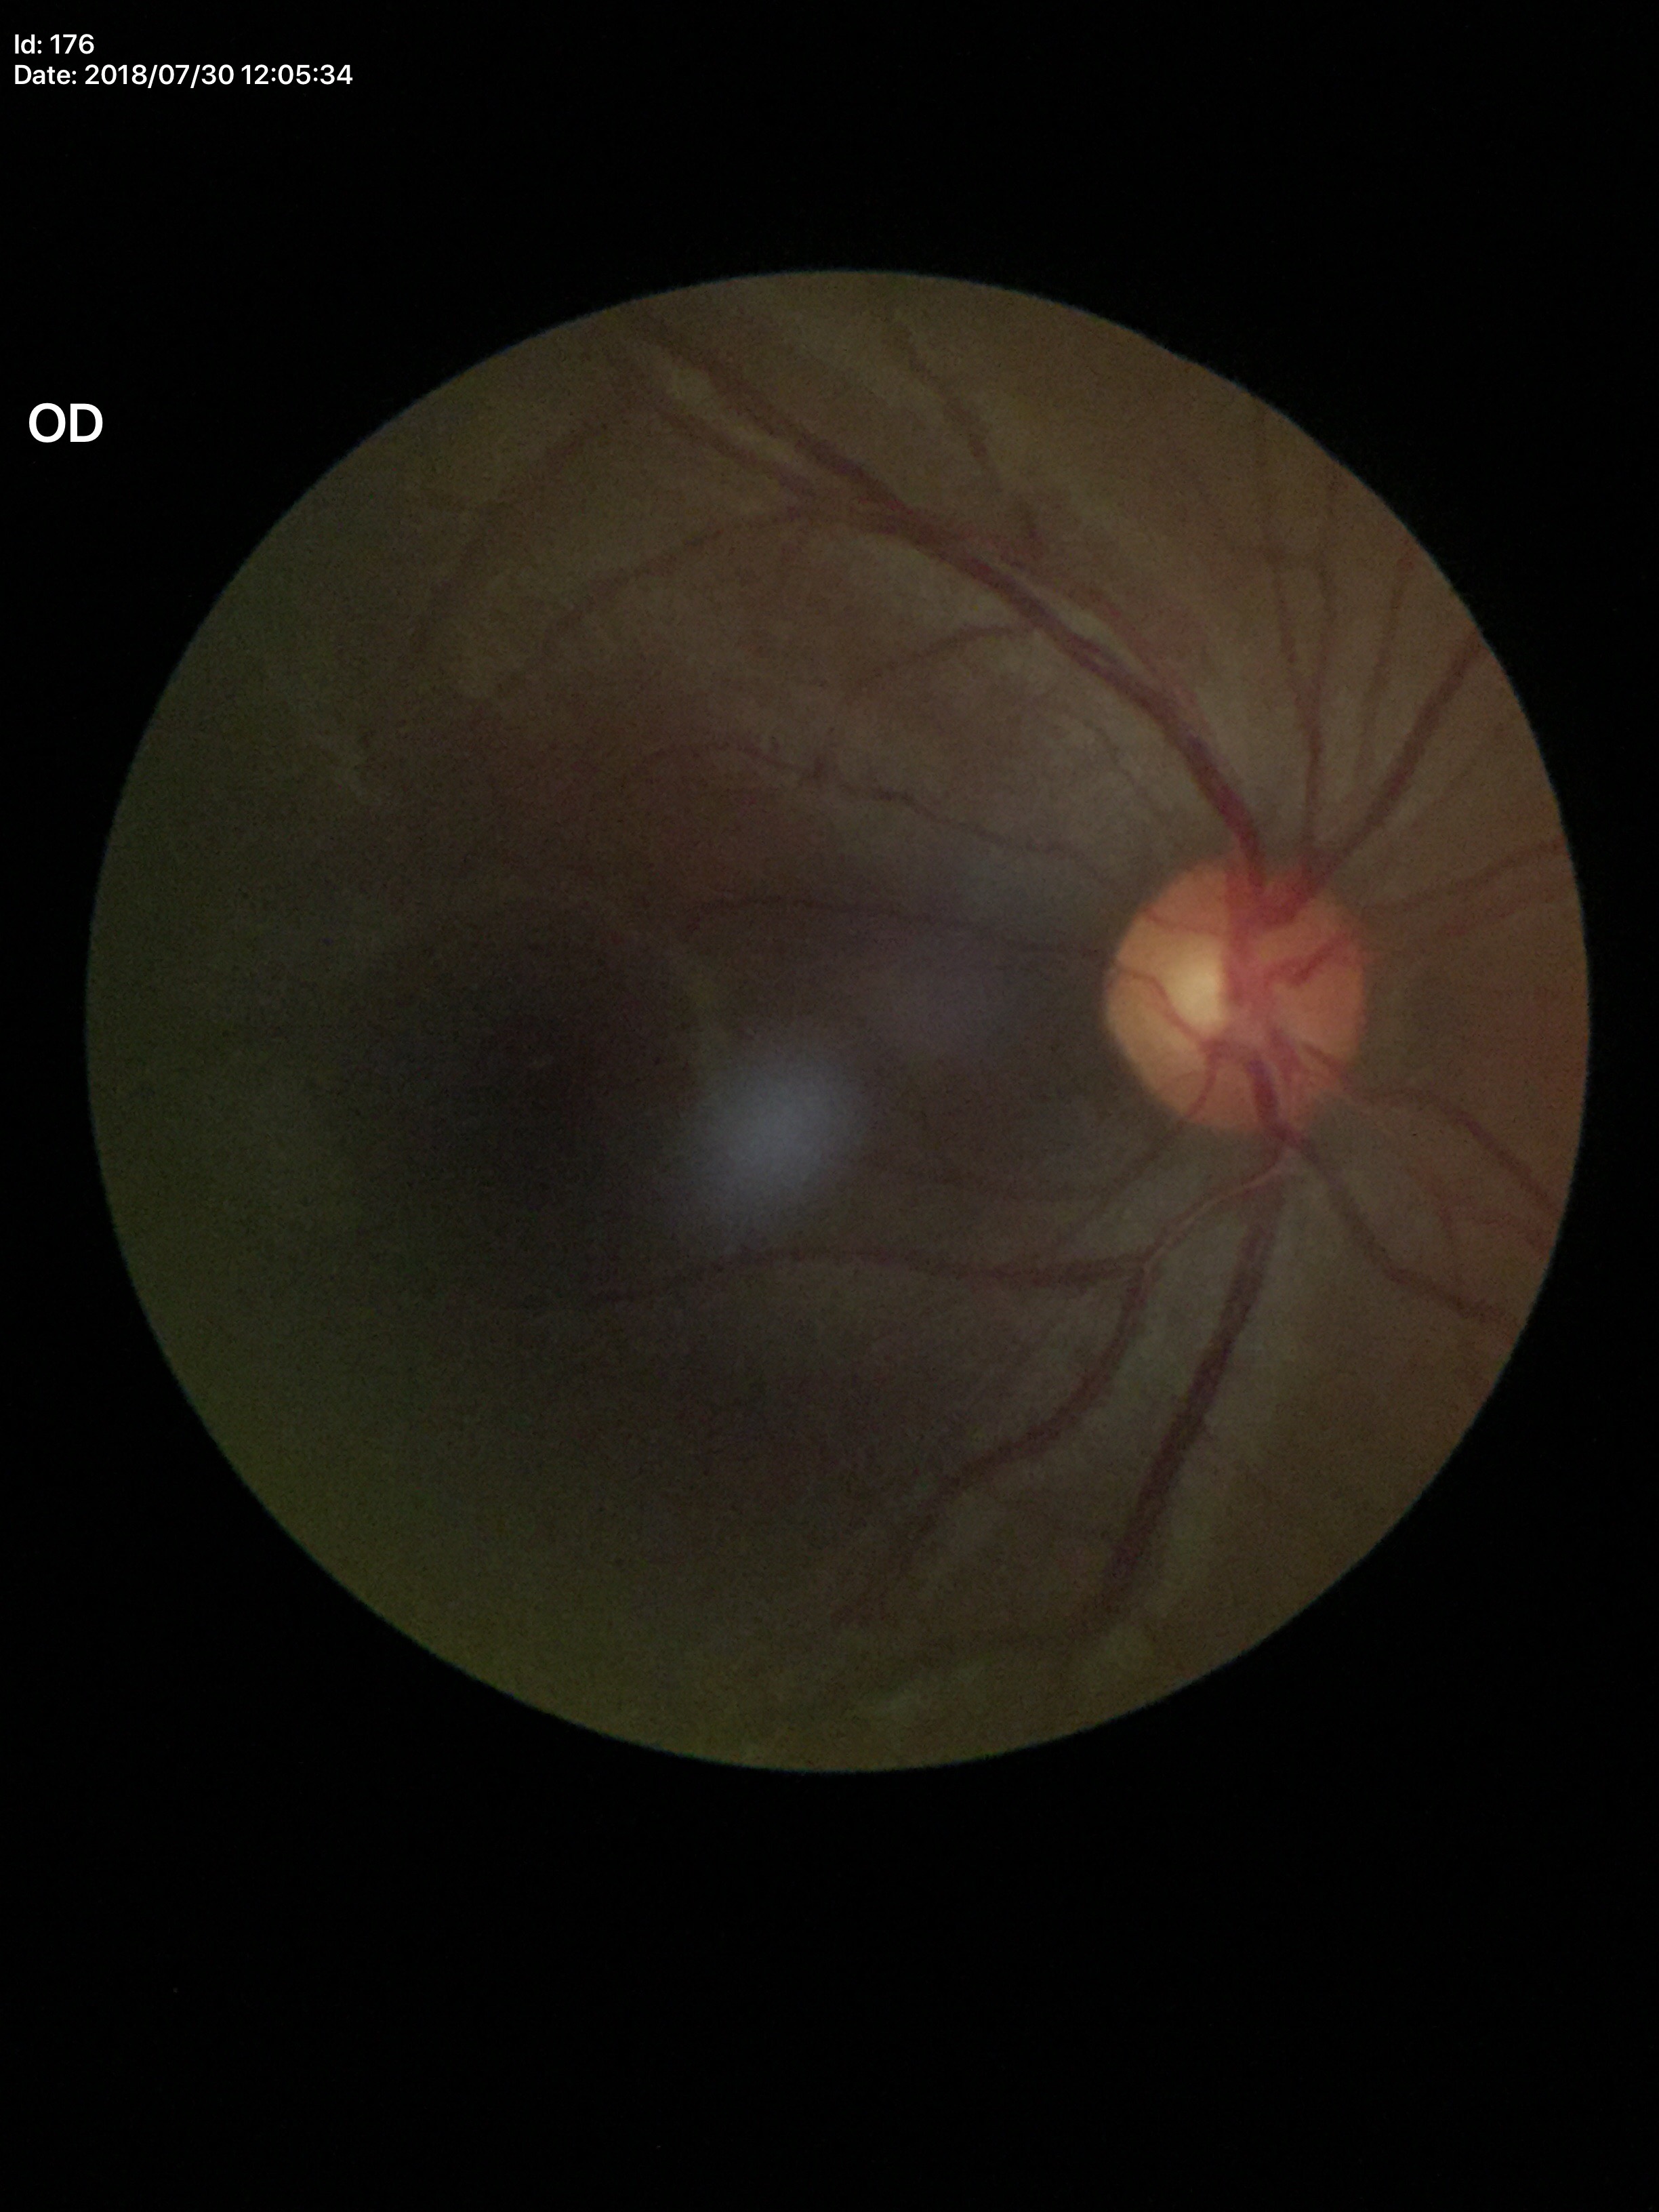

vertical cup-to-disc ratio (VCDR) = 0.45 | Glaucoma screening = no suspicious findings.